Wide-field fundus image from infant ROP screening: 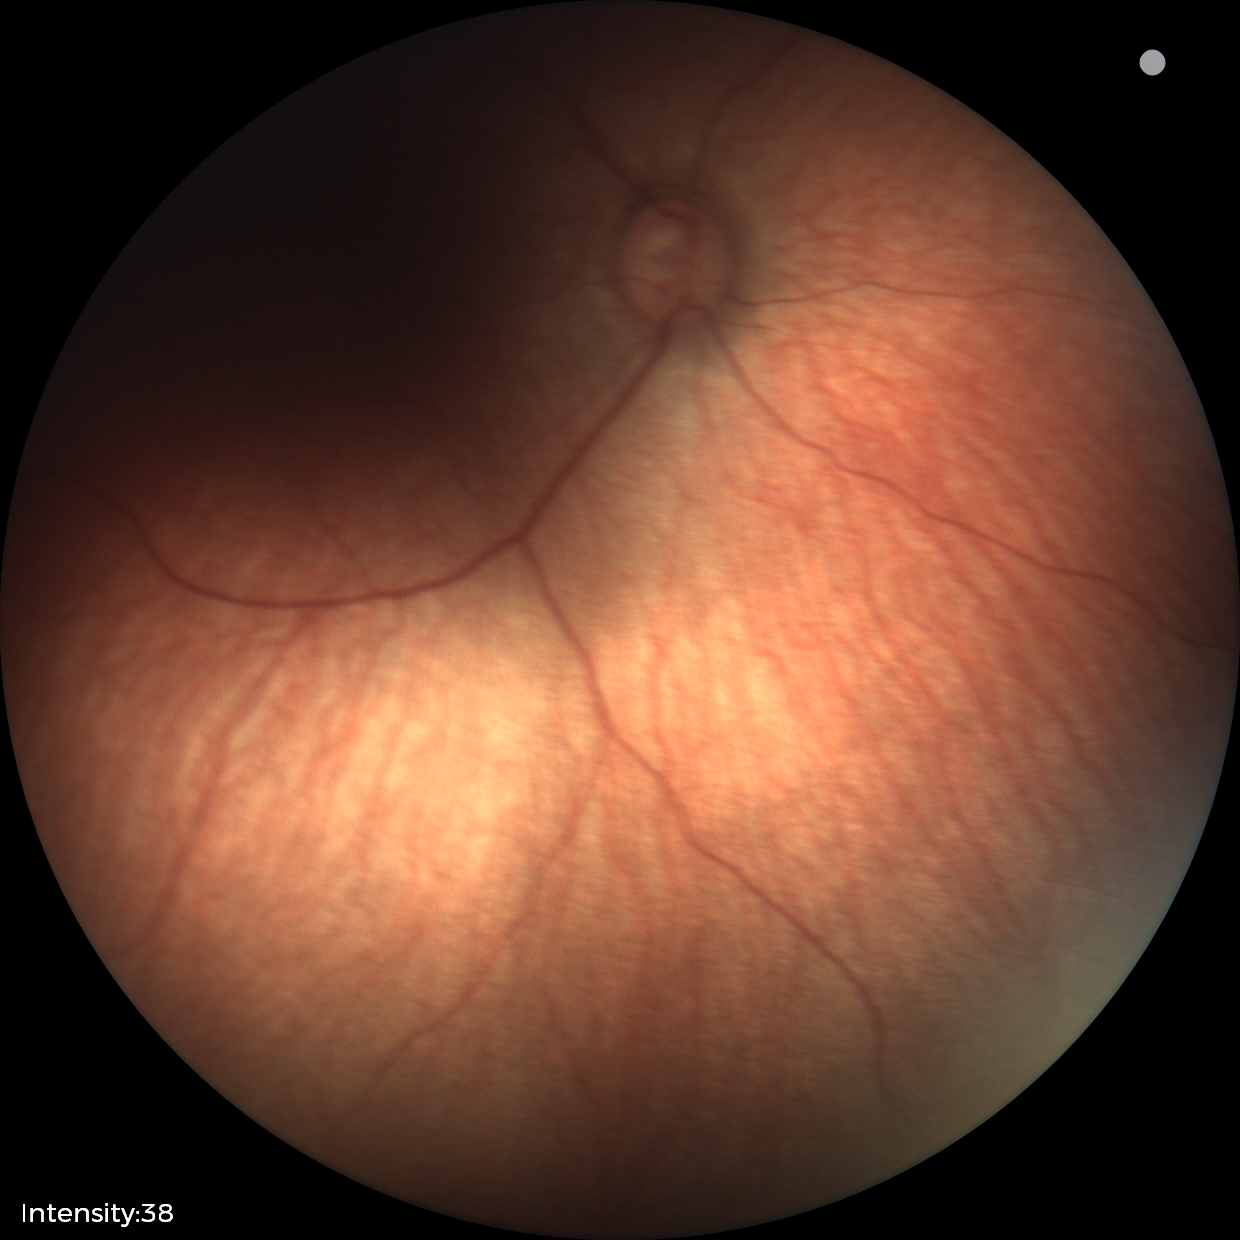

Q: What is the screening diagnosis?
A: no abnormal retinal findings